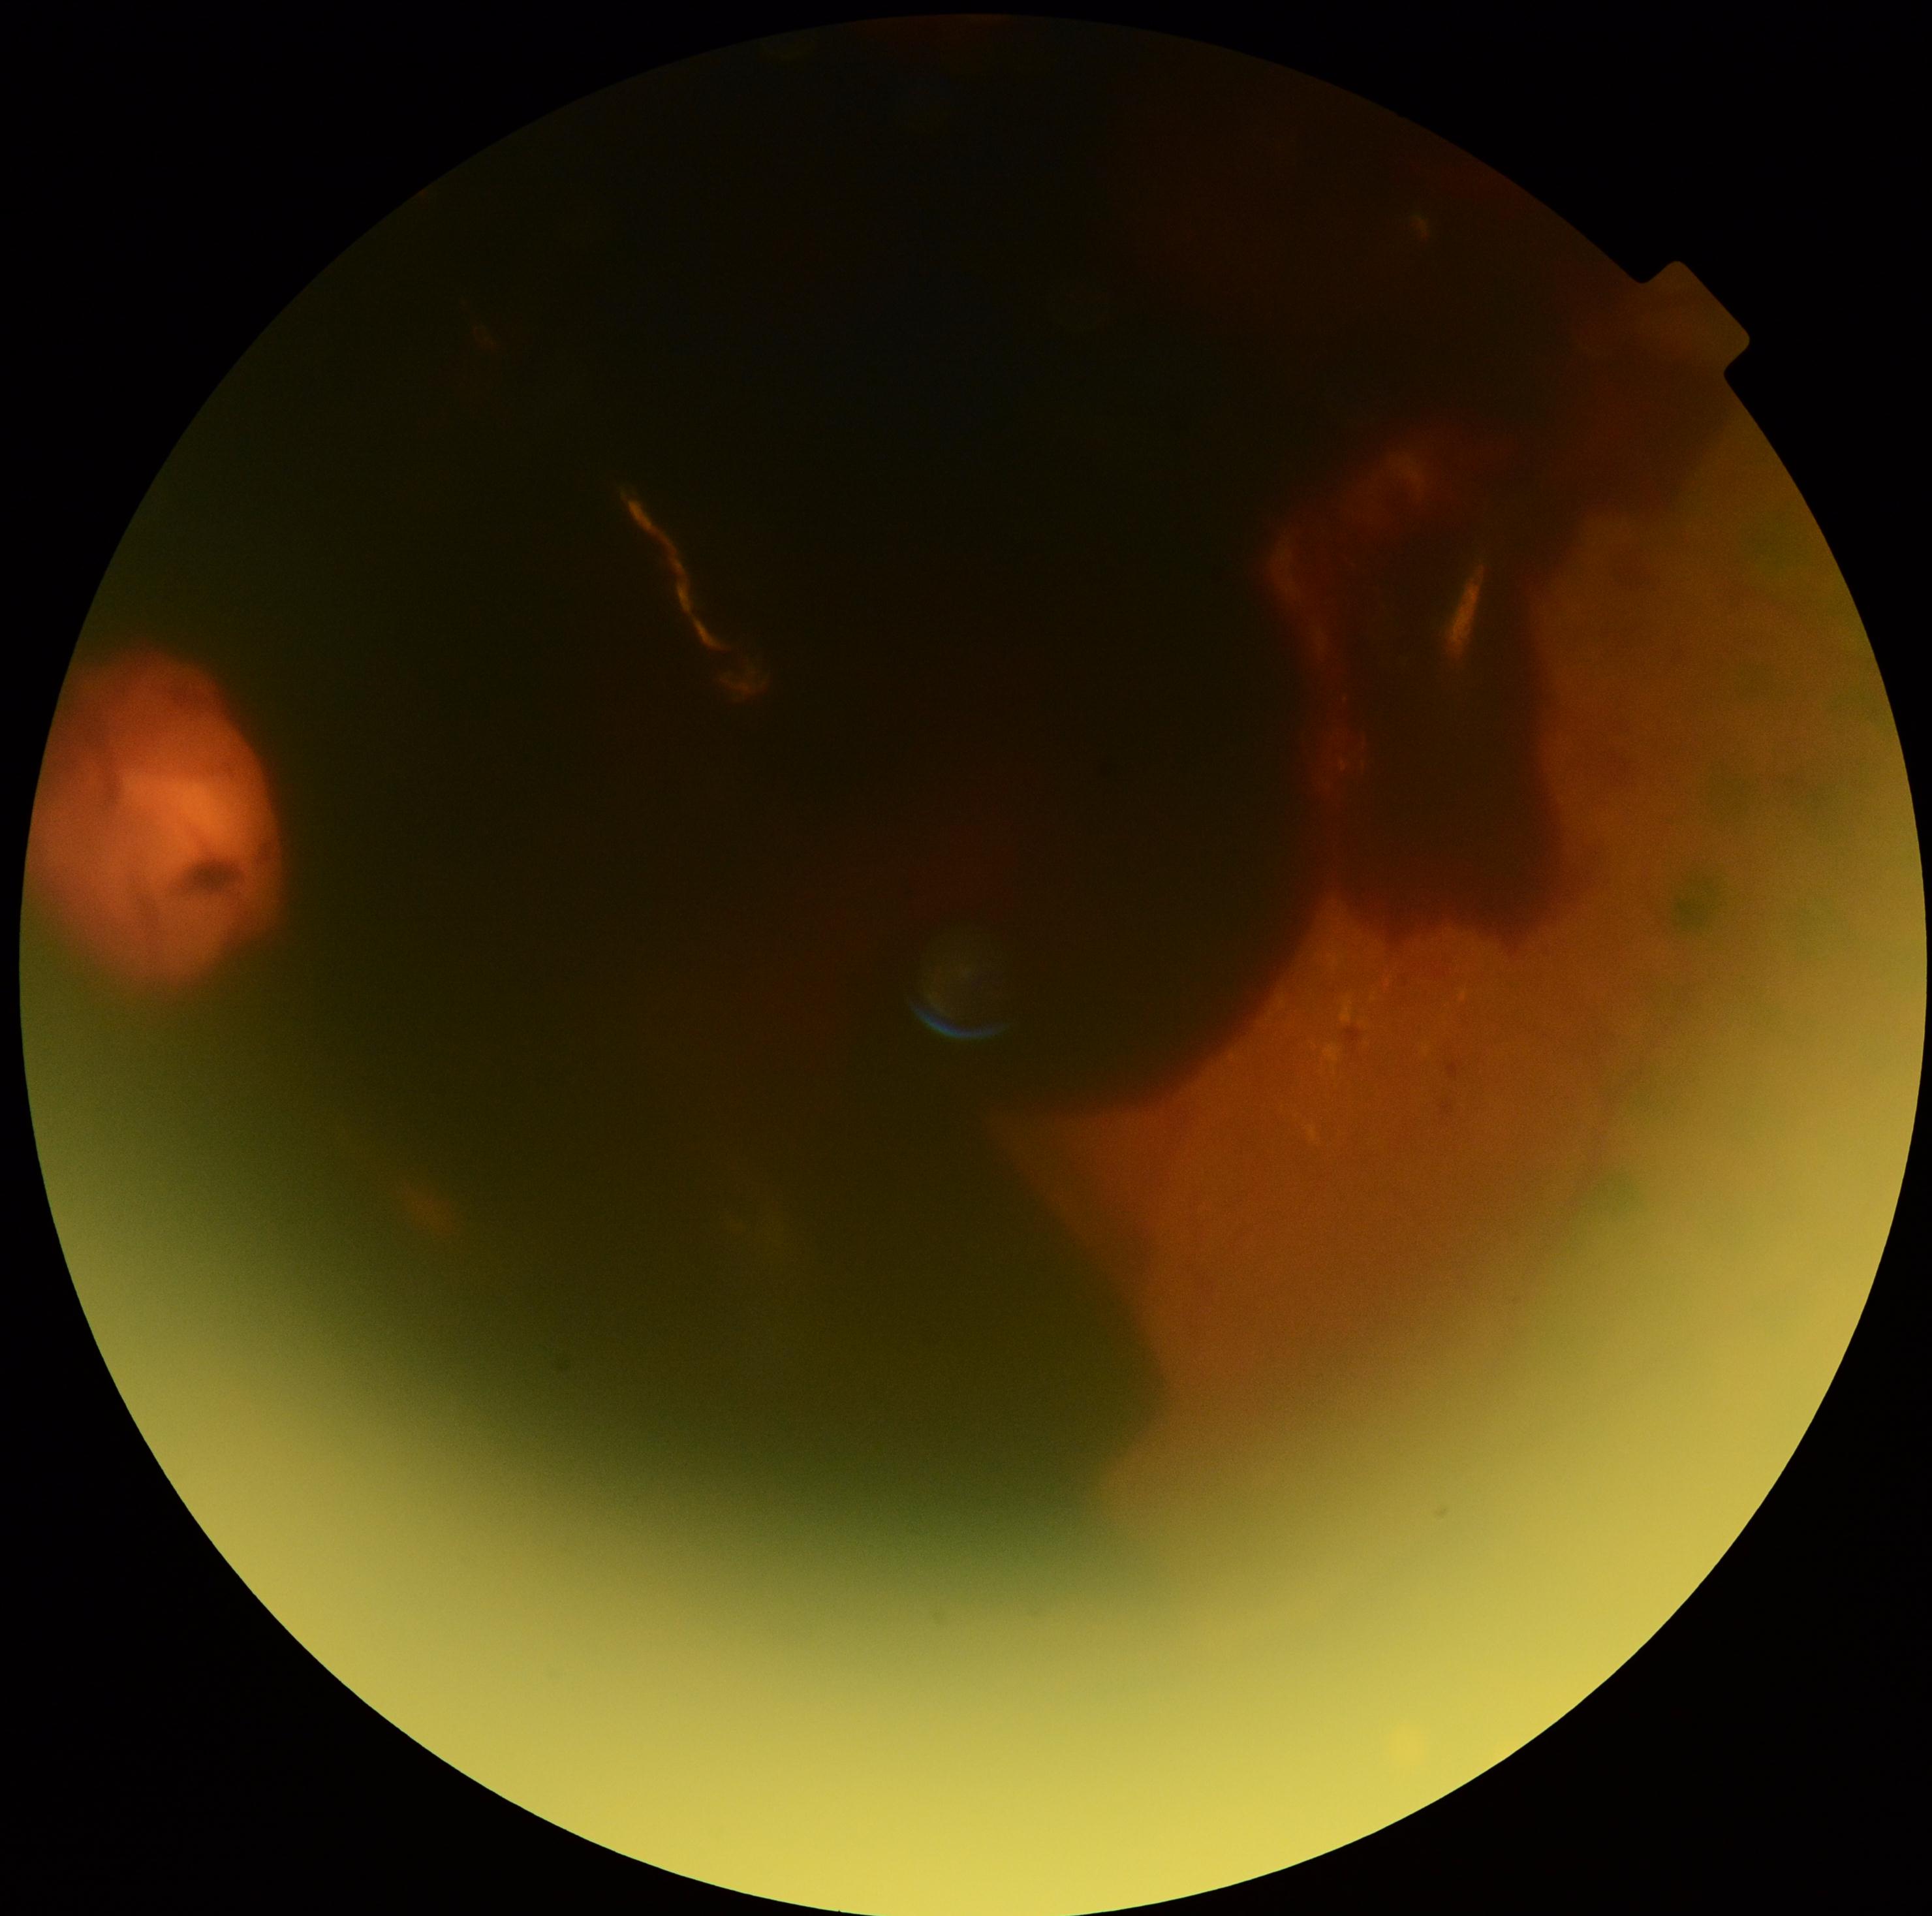

retinopathy=4 — neovascularization and/or vitreous/pre-retinal hemorrhage.